2212x1659px. 45-degree field of view.
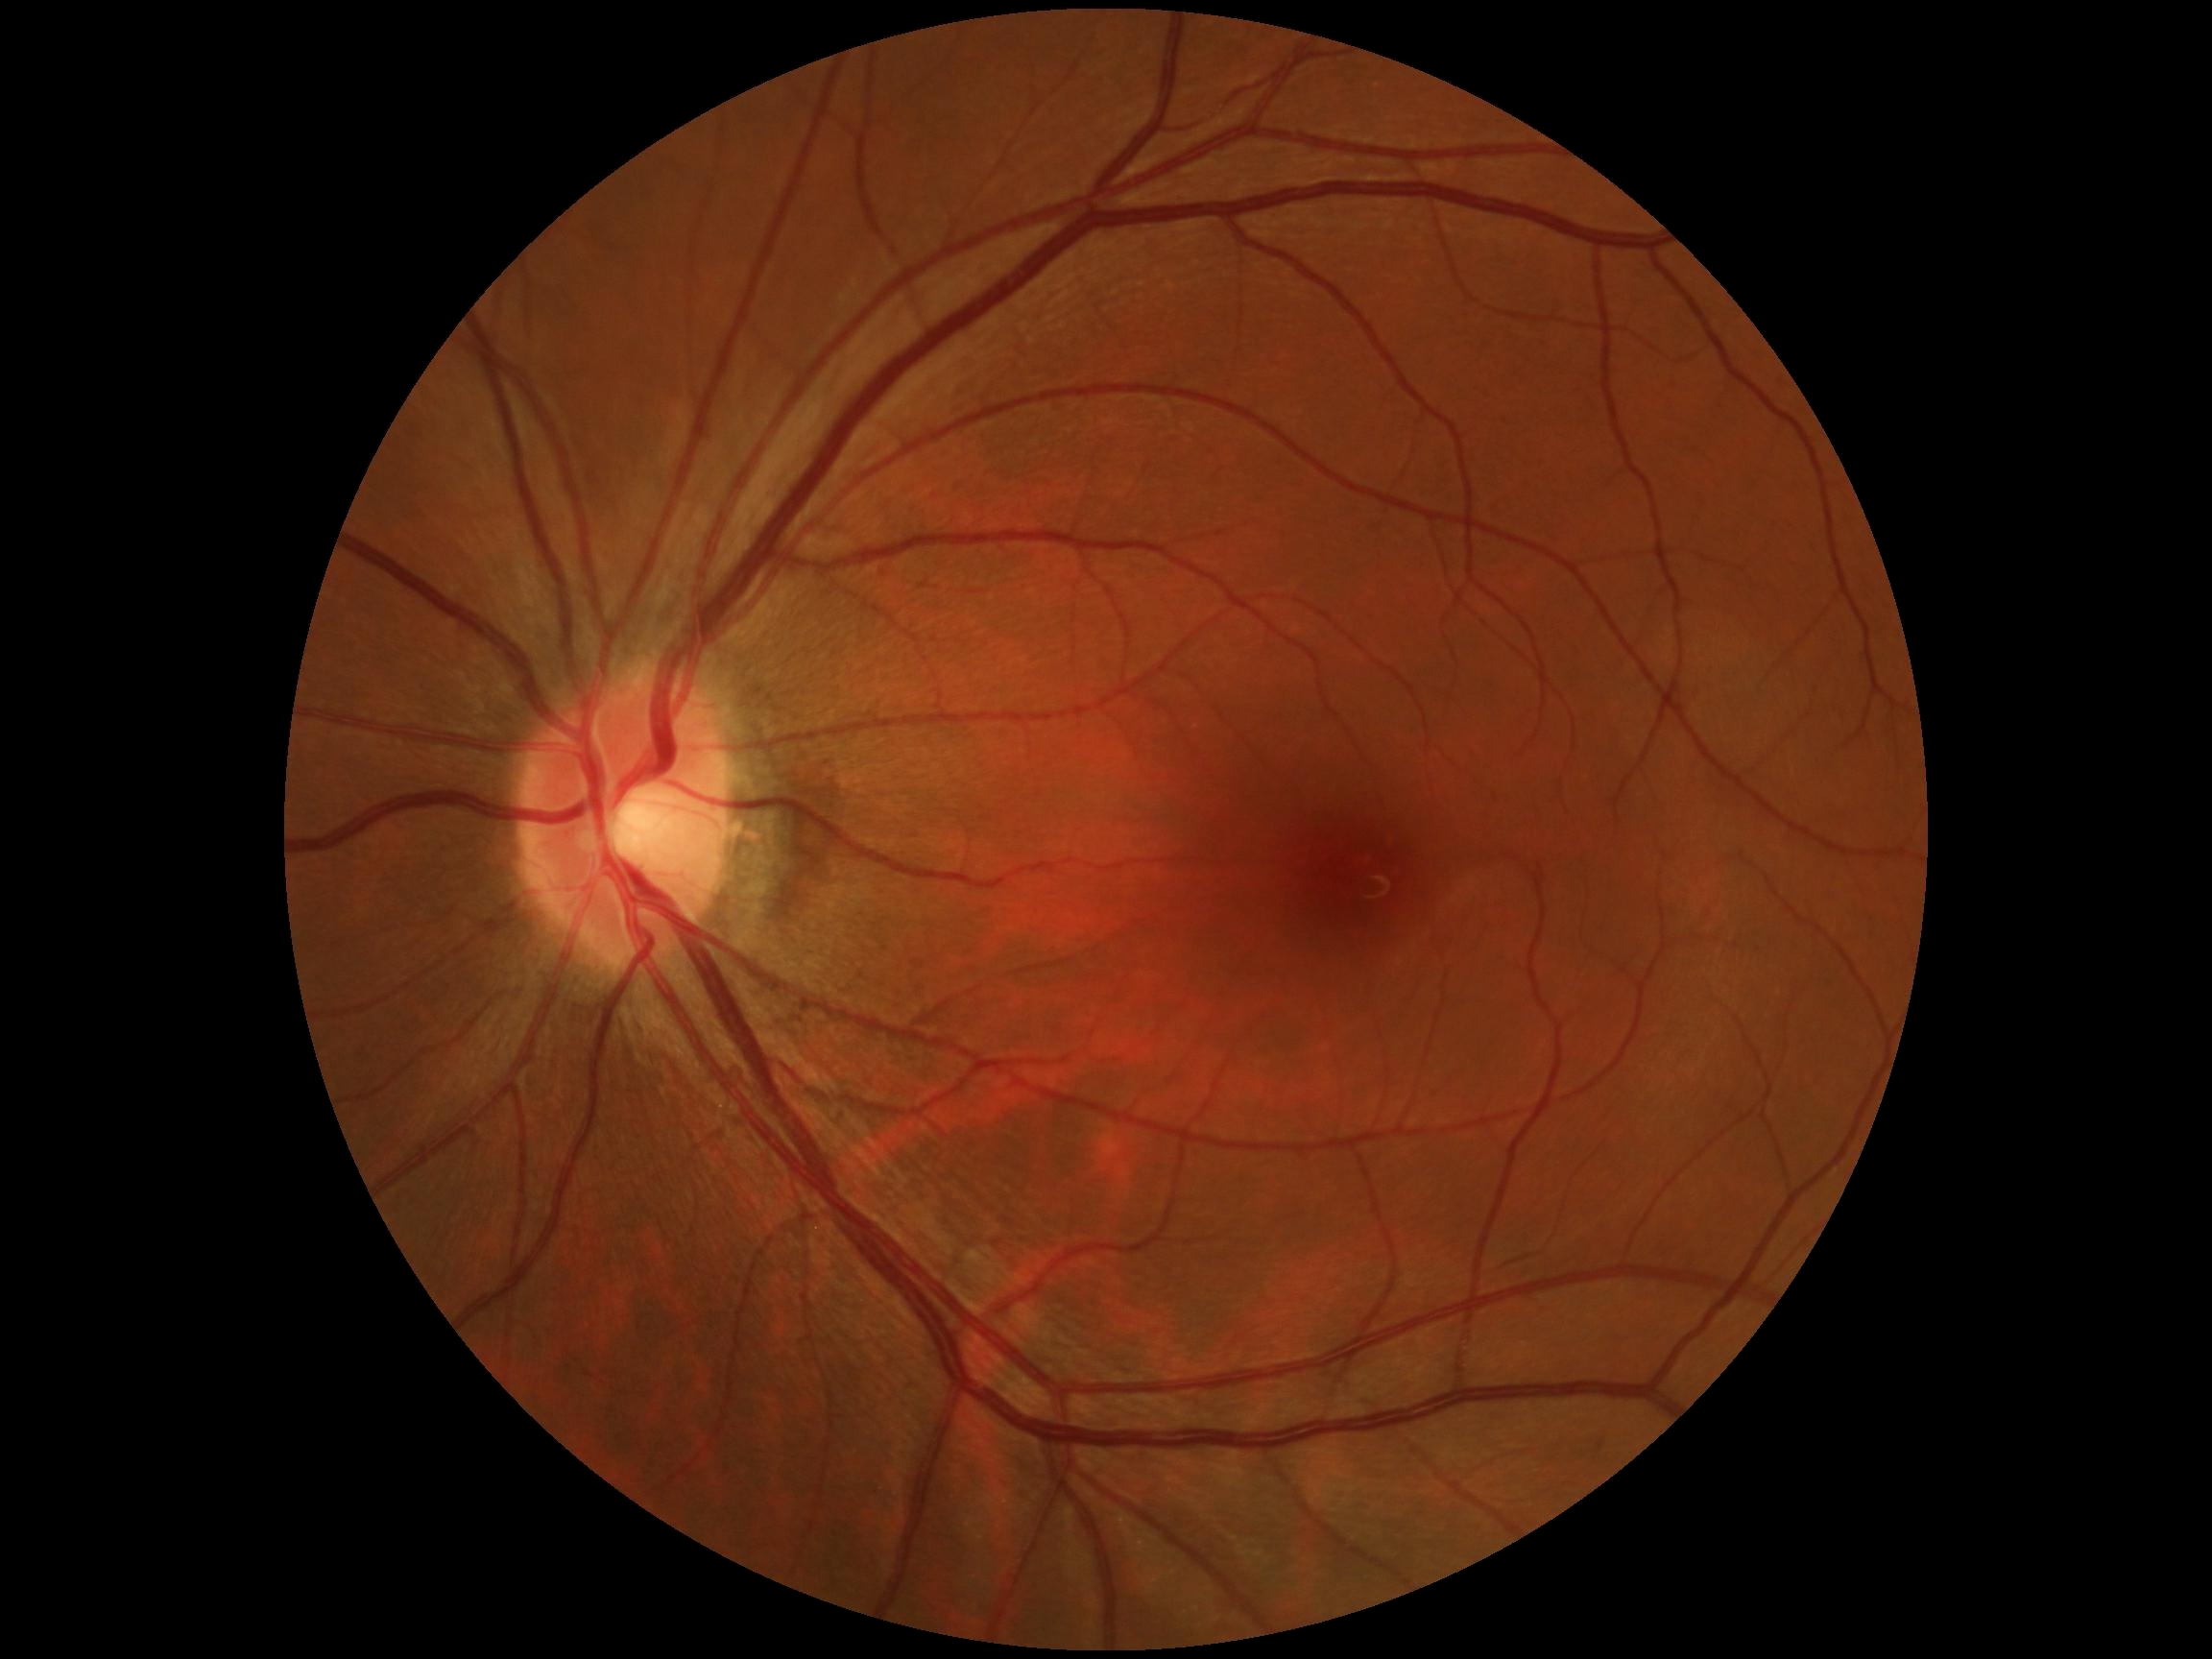
DR severity: 0/4.